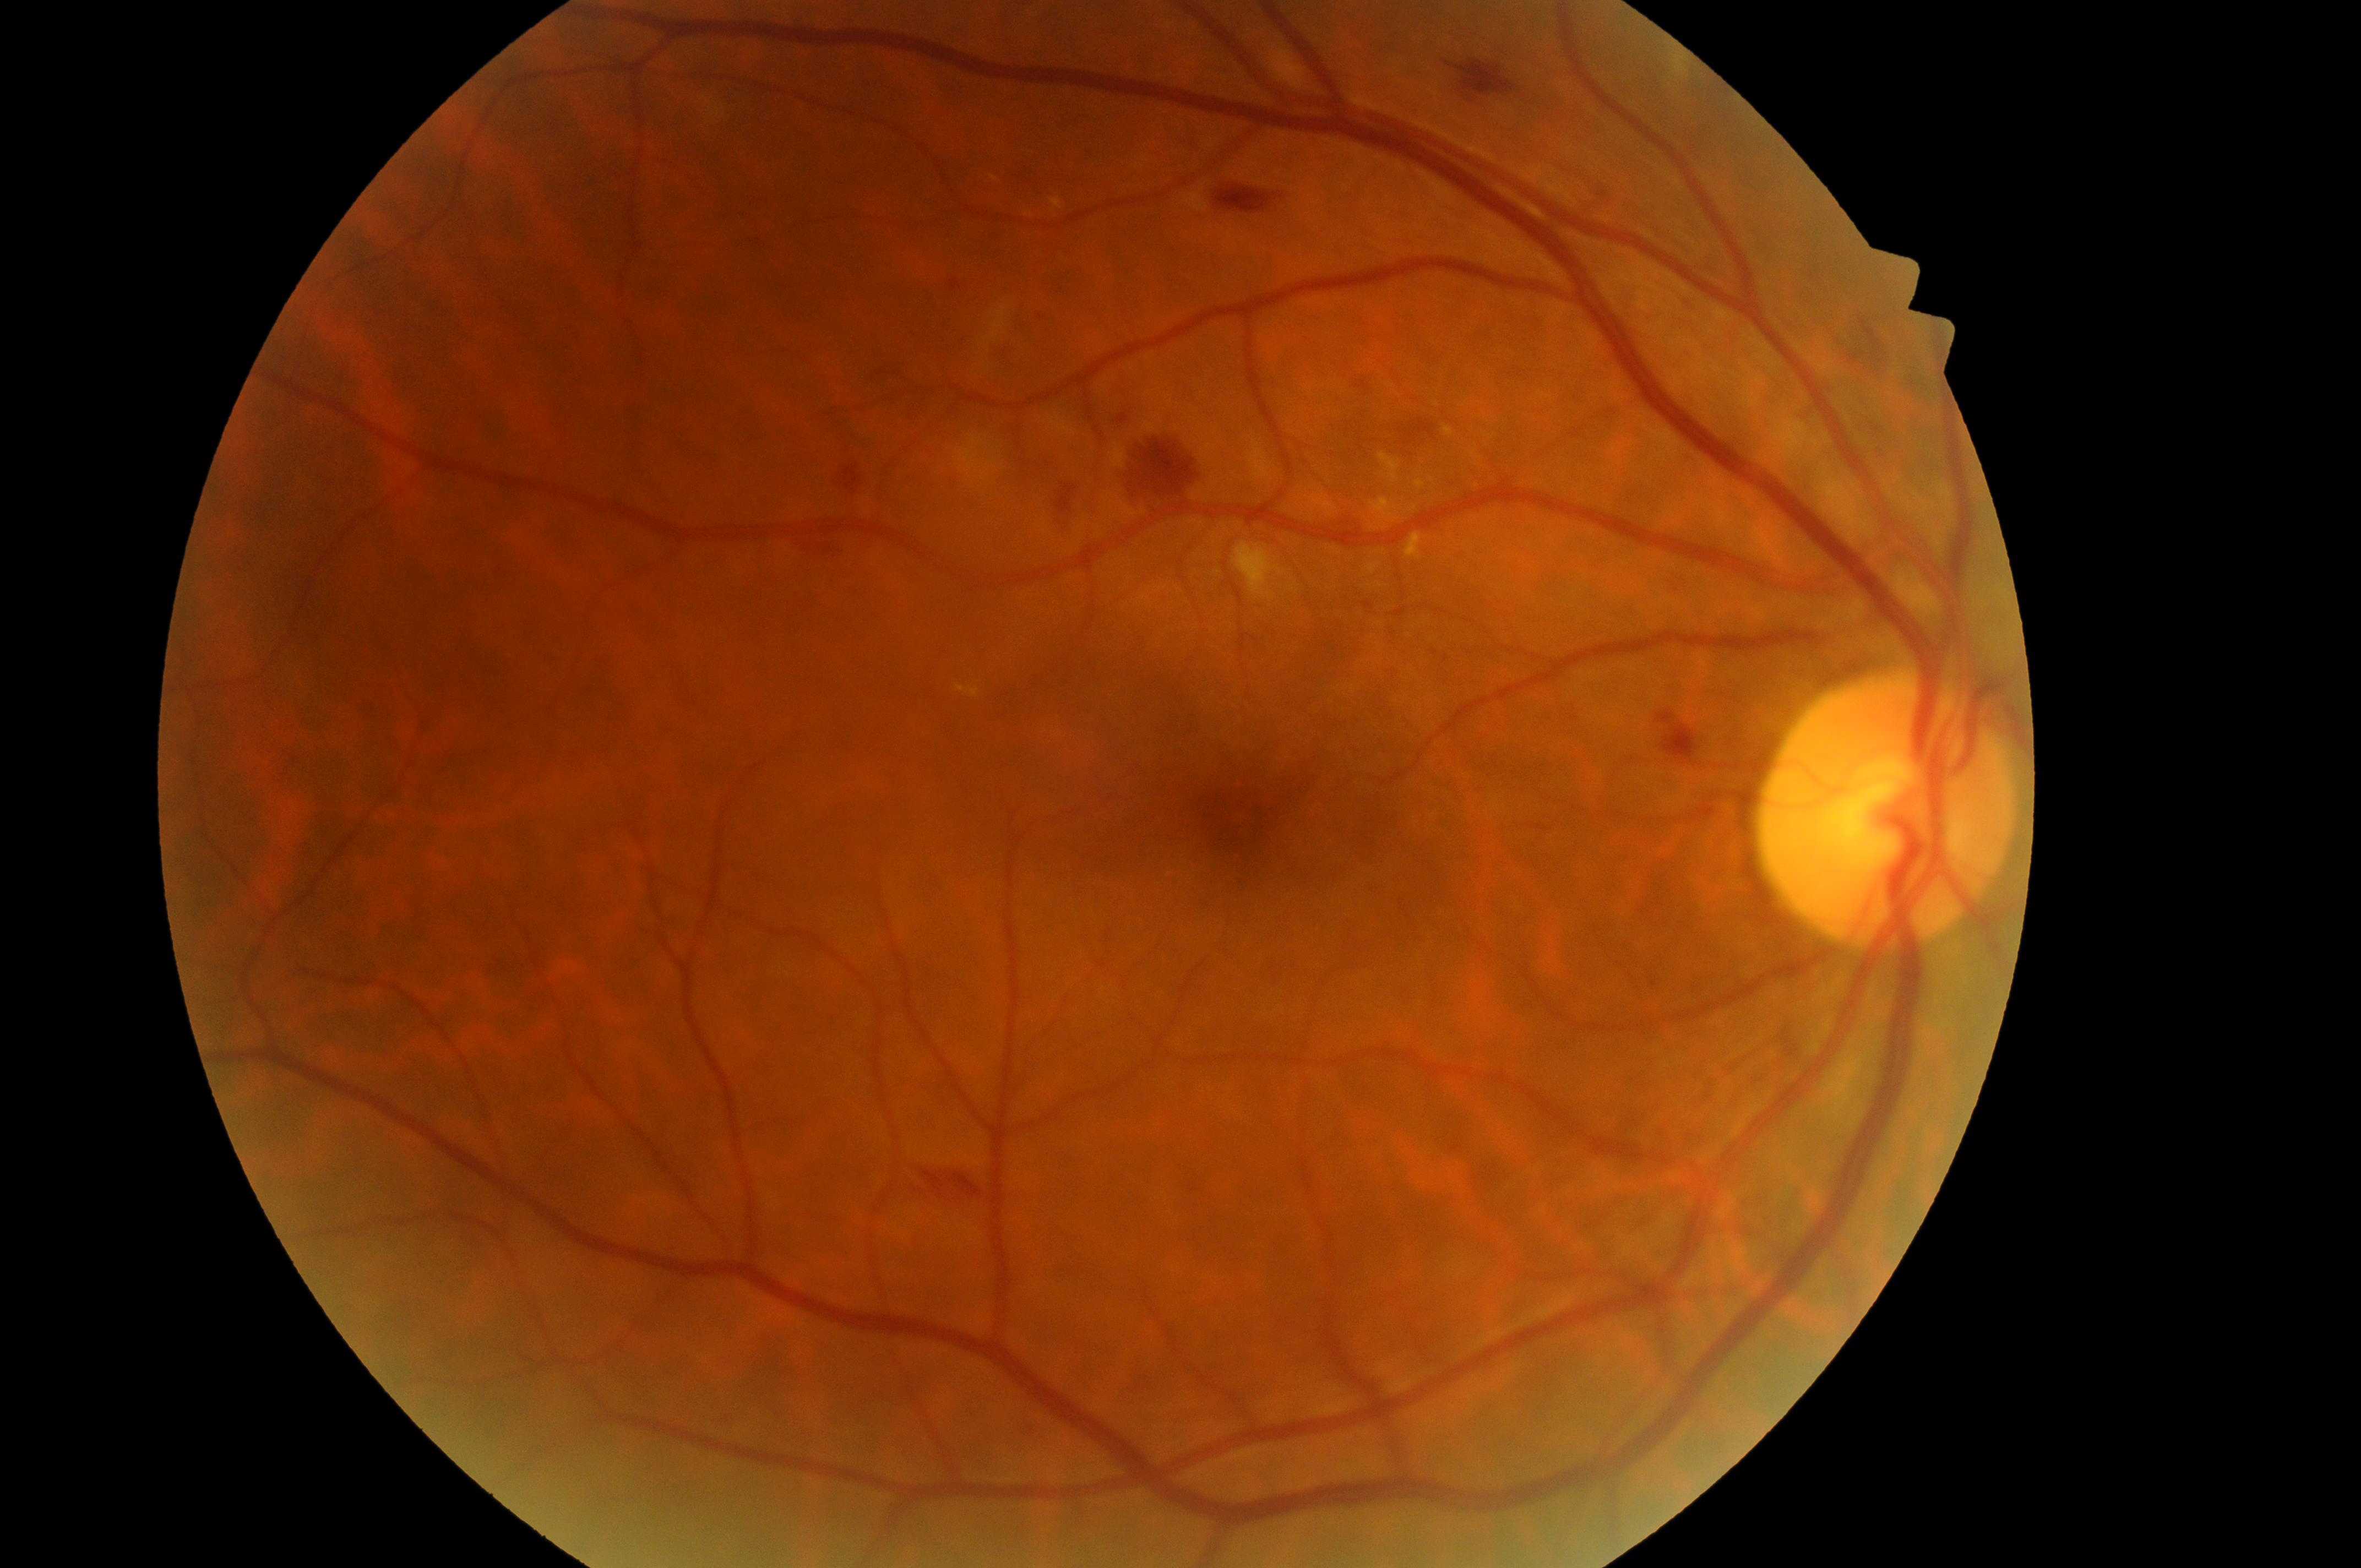

Macular edema: grade 1 (low risk).
Optic disc: (1885, 826).
Foveal center: (1233, 818).
Eye: oculus dexter.
Diabetic retinopathy severity: grade 2 (moderate NPDR).